848x848, acquired with a NIDEK AFC-230 — 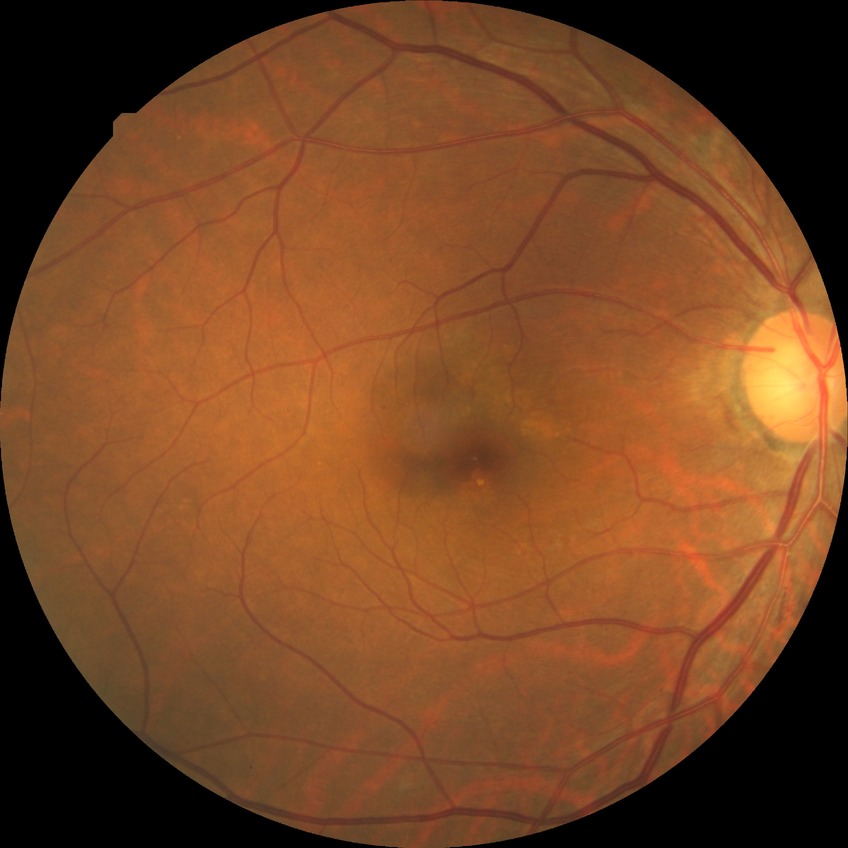

Diabetic retinopathy (DR): SDR (simple diabetic retinopathy).